Modified Davis grading; 848x848px; posterior pole photograph; NIDEK AFC-230 fundus camera; 45 degree fundus photograph: 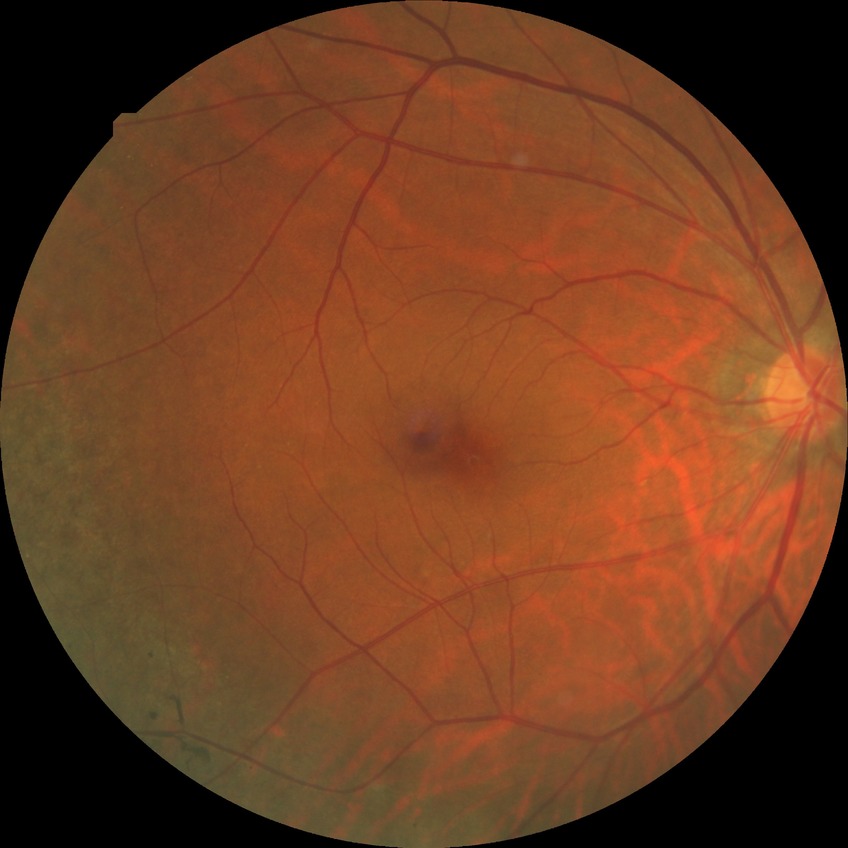

No DR findings.
Davis DR grade: NDR.